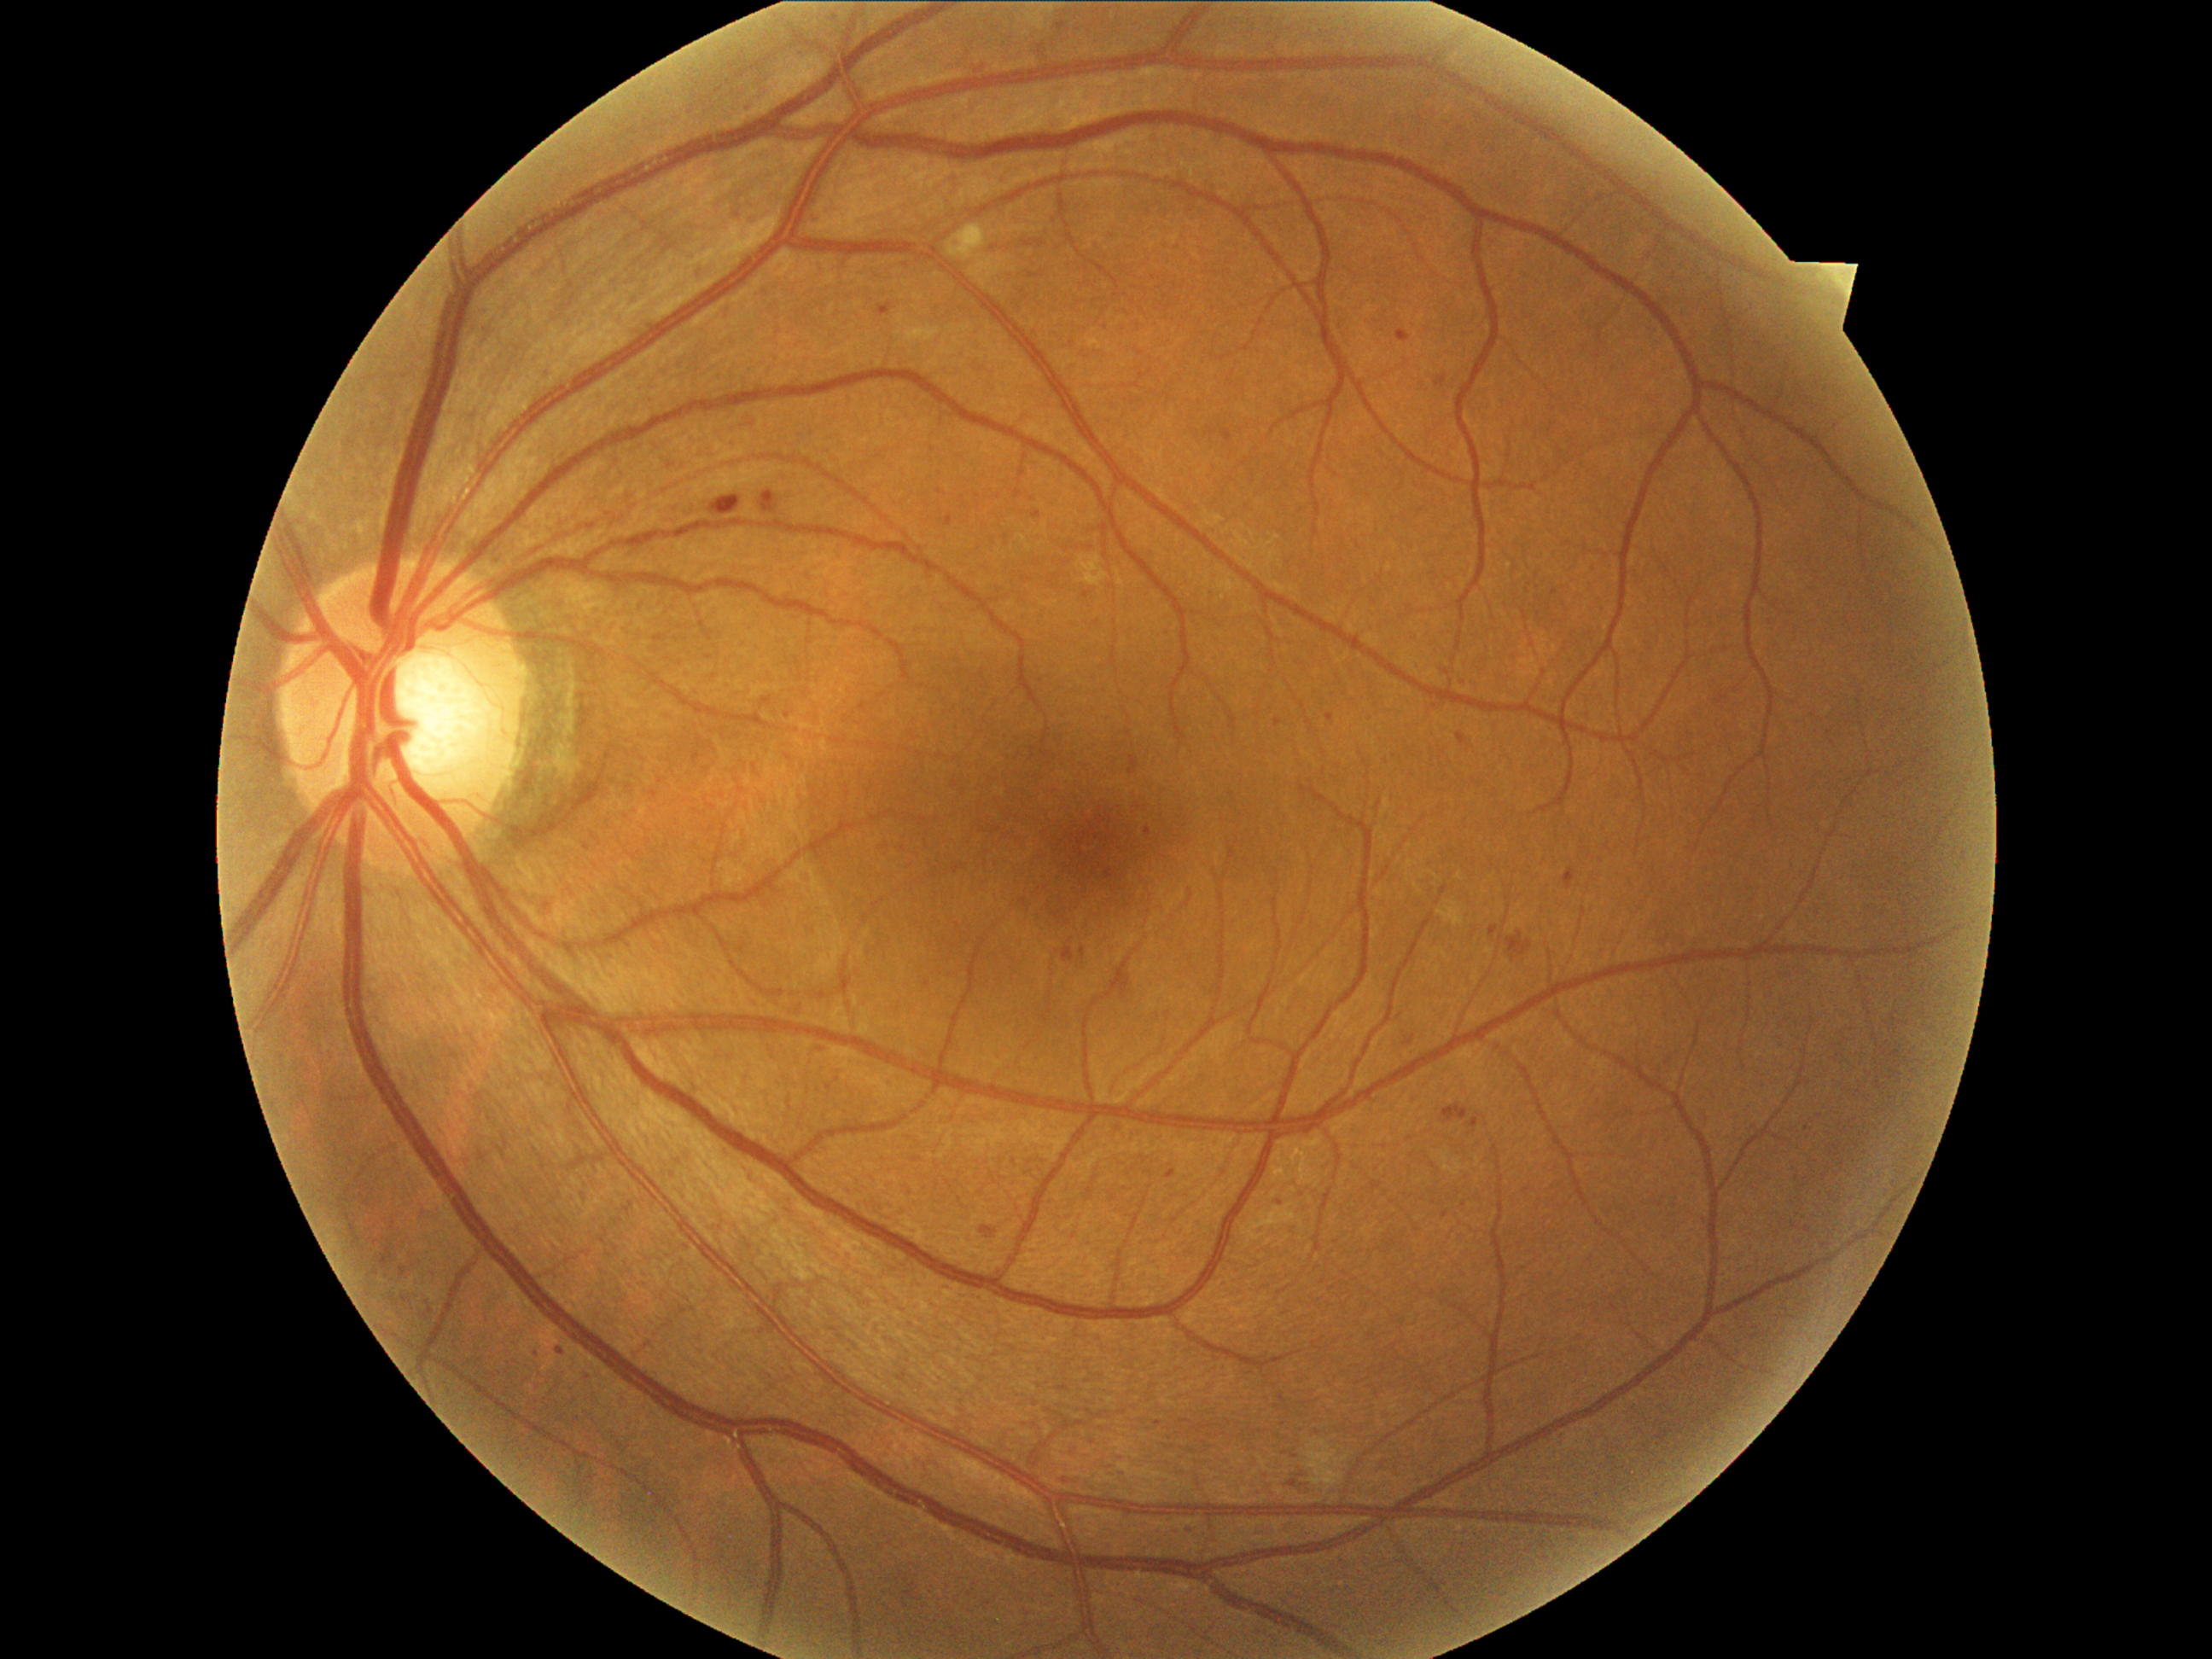
Diabetic retinopathy (DR): grade 2 (moderate NPDR)
A subset of detected lesions:
microaneurysms (MAs) (continued): {"x1": 1278, "y1": 1192, "x2": 1283, "y2": 1201}; {"x1": 1182, "y1": 1518, "x2": 1196, "y2": 1535}; {"x1": 1397, "y1": 330, "x2": 1411, "y2": 344}; {"x1": 557, "y1": 1348, "x2": 564, "y2": 1356}; {"x1": 1274, "y1": 719, "x2": 1283, "y2": 726}; {"x1": 946, "y1": 516, "x2": 953, "y2": 527}; {"x1": 1033, "y1": 511, "x2": 1042, "y2": 520}; {"x1": 1457, "y1": 733, "x2": 1469, "y2": 747}; {"x1": 1406, "y1": 1037, "x2": 1416, "y2": 1045}; {"x1": 745, "y1": 105, "x2": 754, "y2": 117}; {"x1": 1091, "y1": 859, "x2": 1117, "y2": 882}; {"x1": 1144, "y1": 827, "x2": 1151, "y2": 837}; {"x1": 981, "y1": 1226, "x2": 996, "y2": 1235}; {"x1": 1436, "y1": 376, "x2": 1447, "y2": 387}
MAs (small, approximate centers) near 431/1311; 584/1372; 822/1050; 1158/1423; 788/715